Color fundus photograph; NIDEK AFC-230 fundus camera; 848x848px; 45-degree field of view; no pharmacologic dilation.
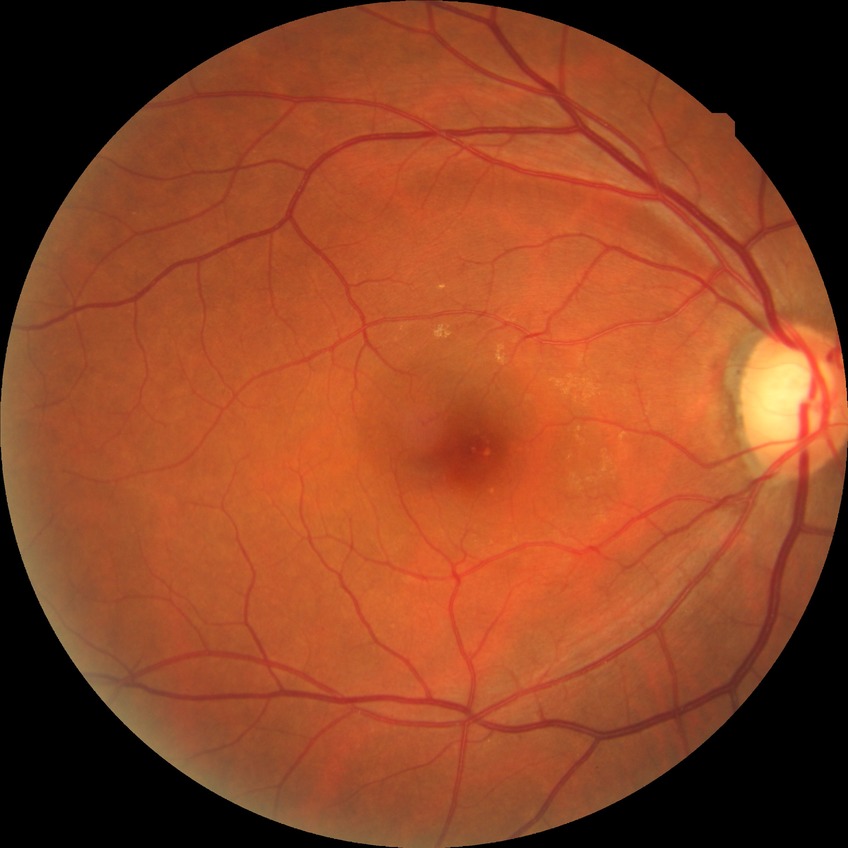 Diabetic retinopathy (DR) is NDR (no diabetic retinopathy).